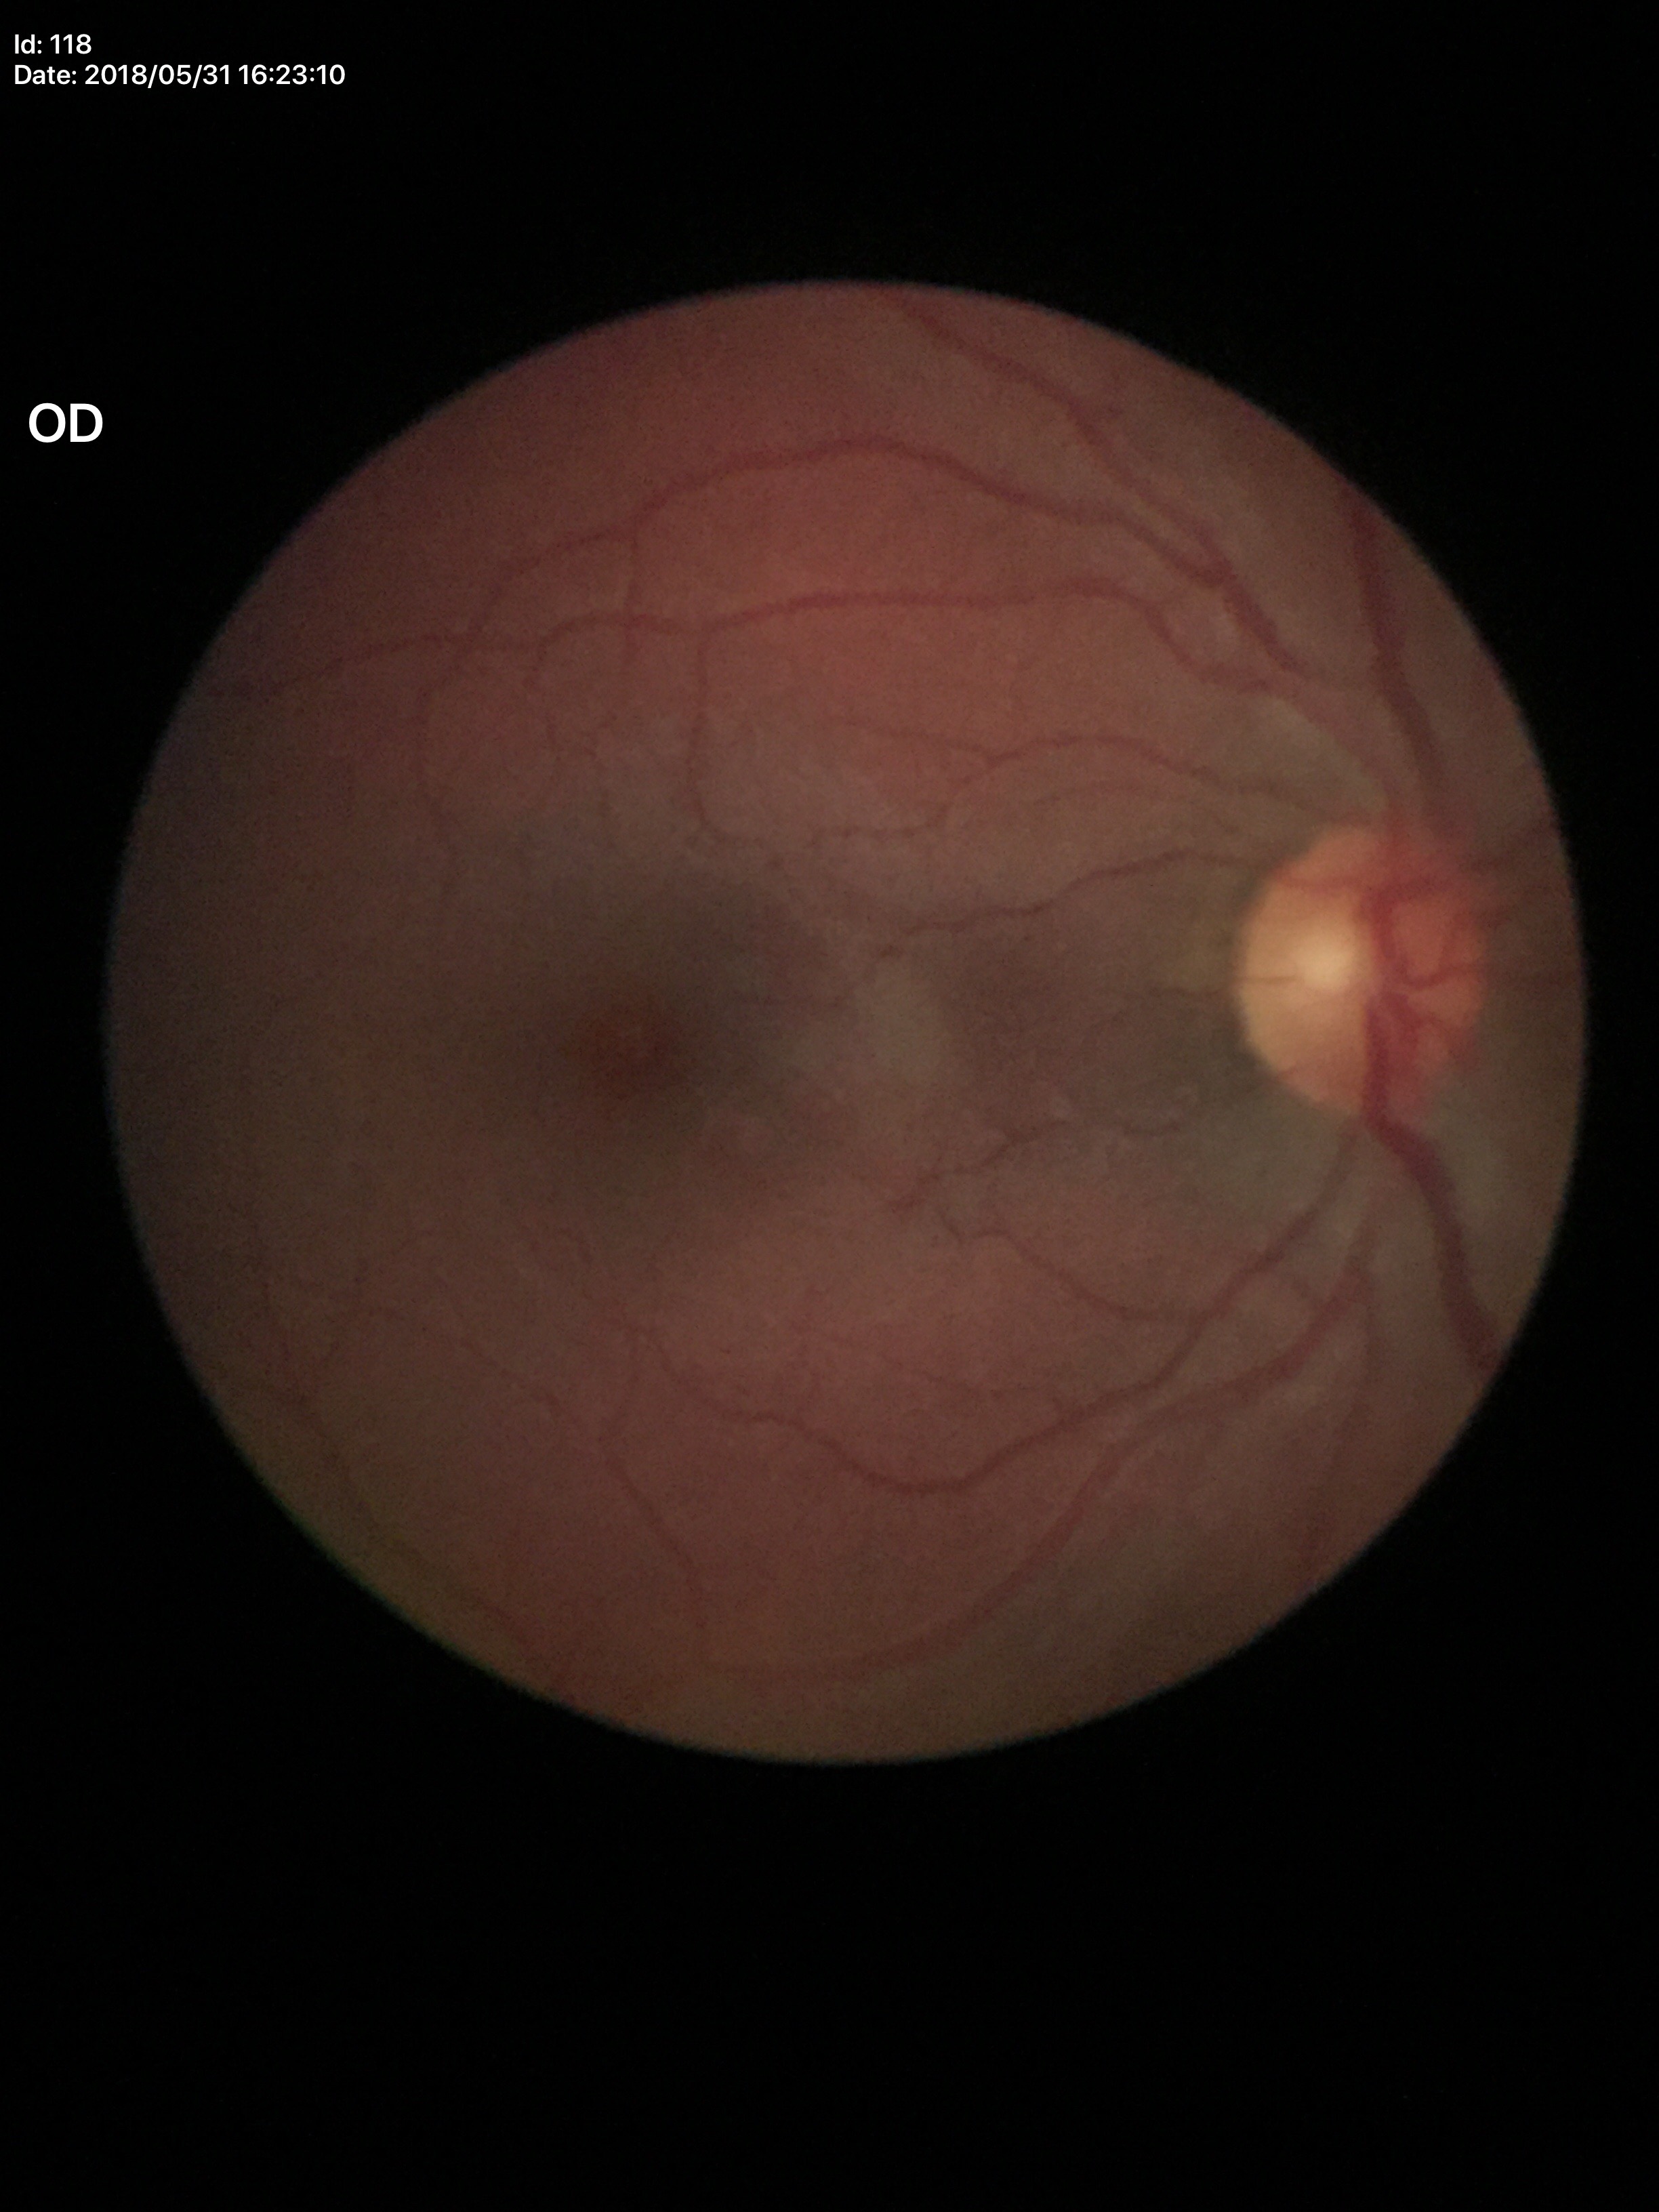

Q: What is the glaucoma assessment?
A: negative
Q: What is the VCDR?
A: 0.47
Q: Horizontal CDR?
A: 0.50